Wide-field fundus photograph of an infant
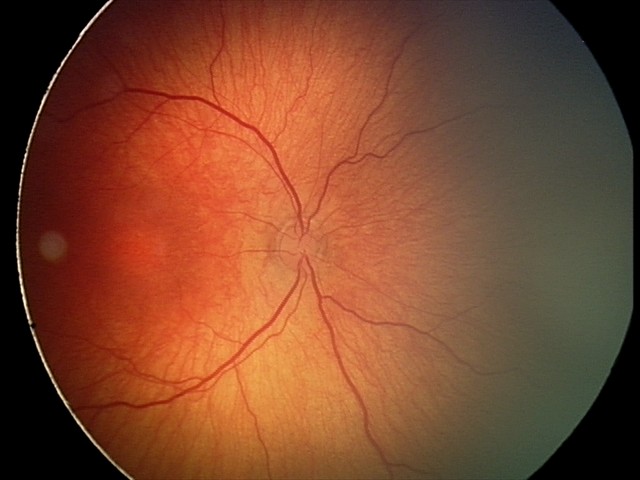
No plus disease.
Series diagnosed as retinopathy of prematurity (ROP) stage 2.